NIDEK AFC-230 · color fundus image · 45° field of view.
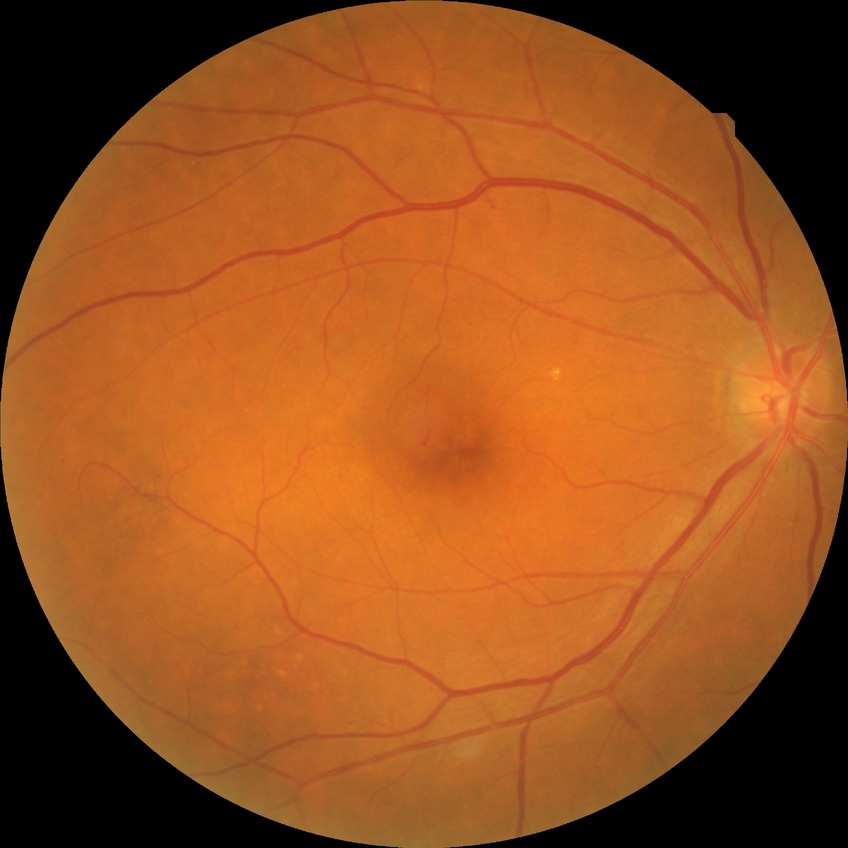 DR class: non-proliferative diabetic retinopathy. Diabetic retinopathy (DR) is SDR (simple diabetic retinopathy).